Wide-field contact fundus photograph of an infant · 1440 by 1080 pixels: 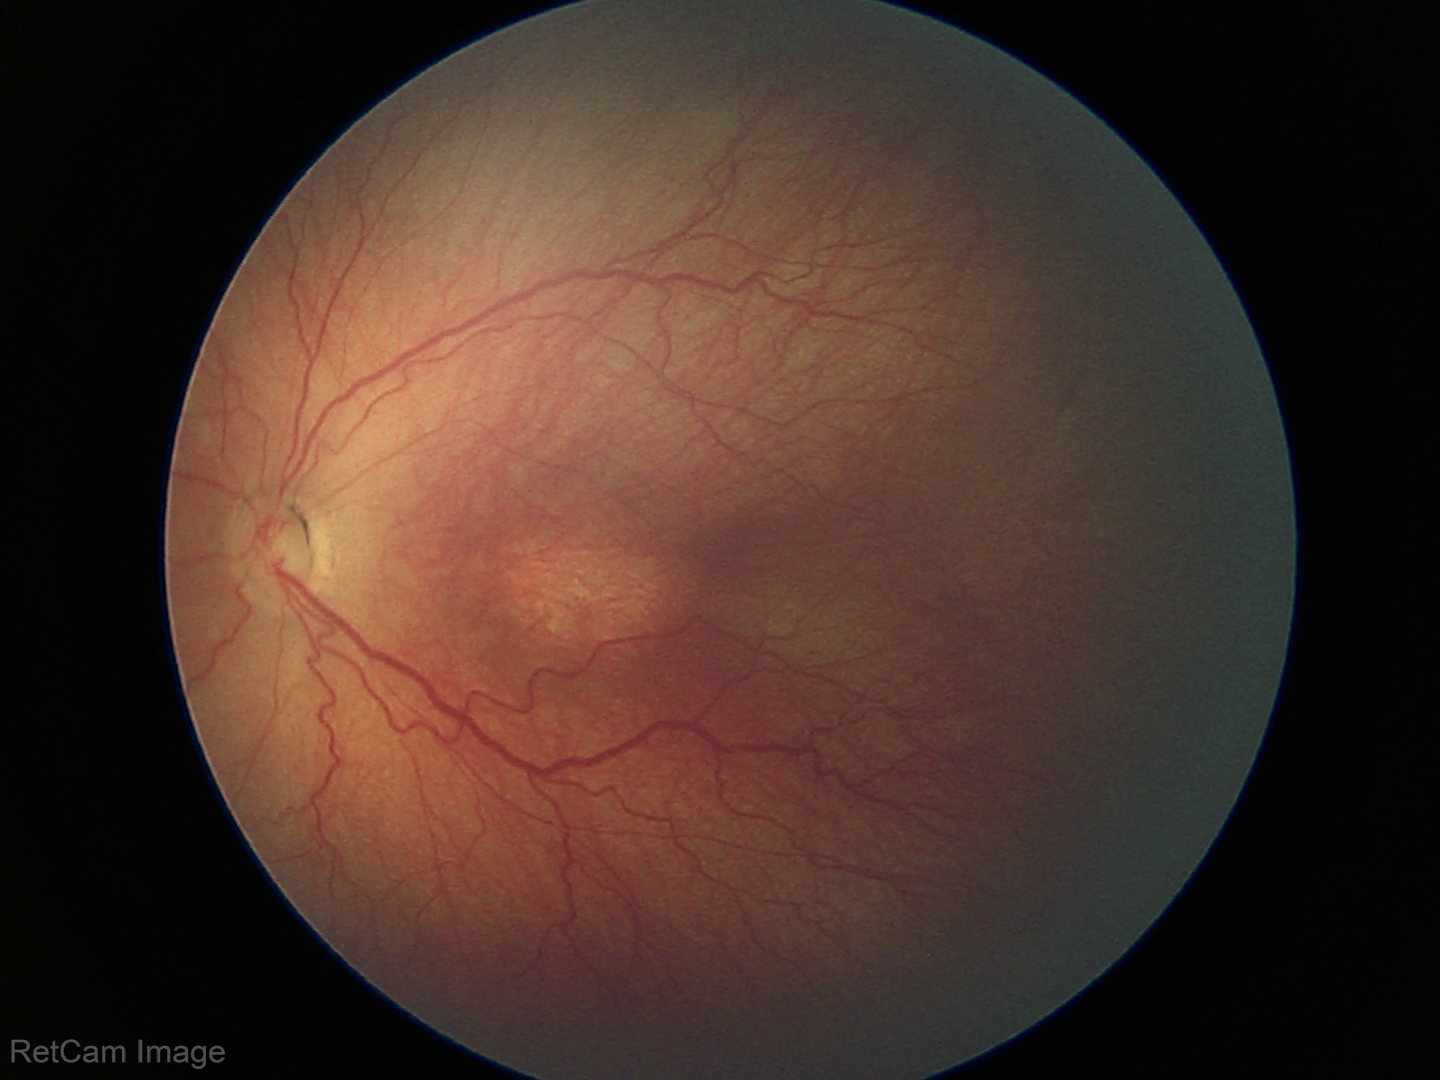 Screening: retinopathy of prematurity (ROP) stage 3.